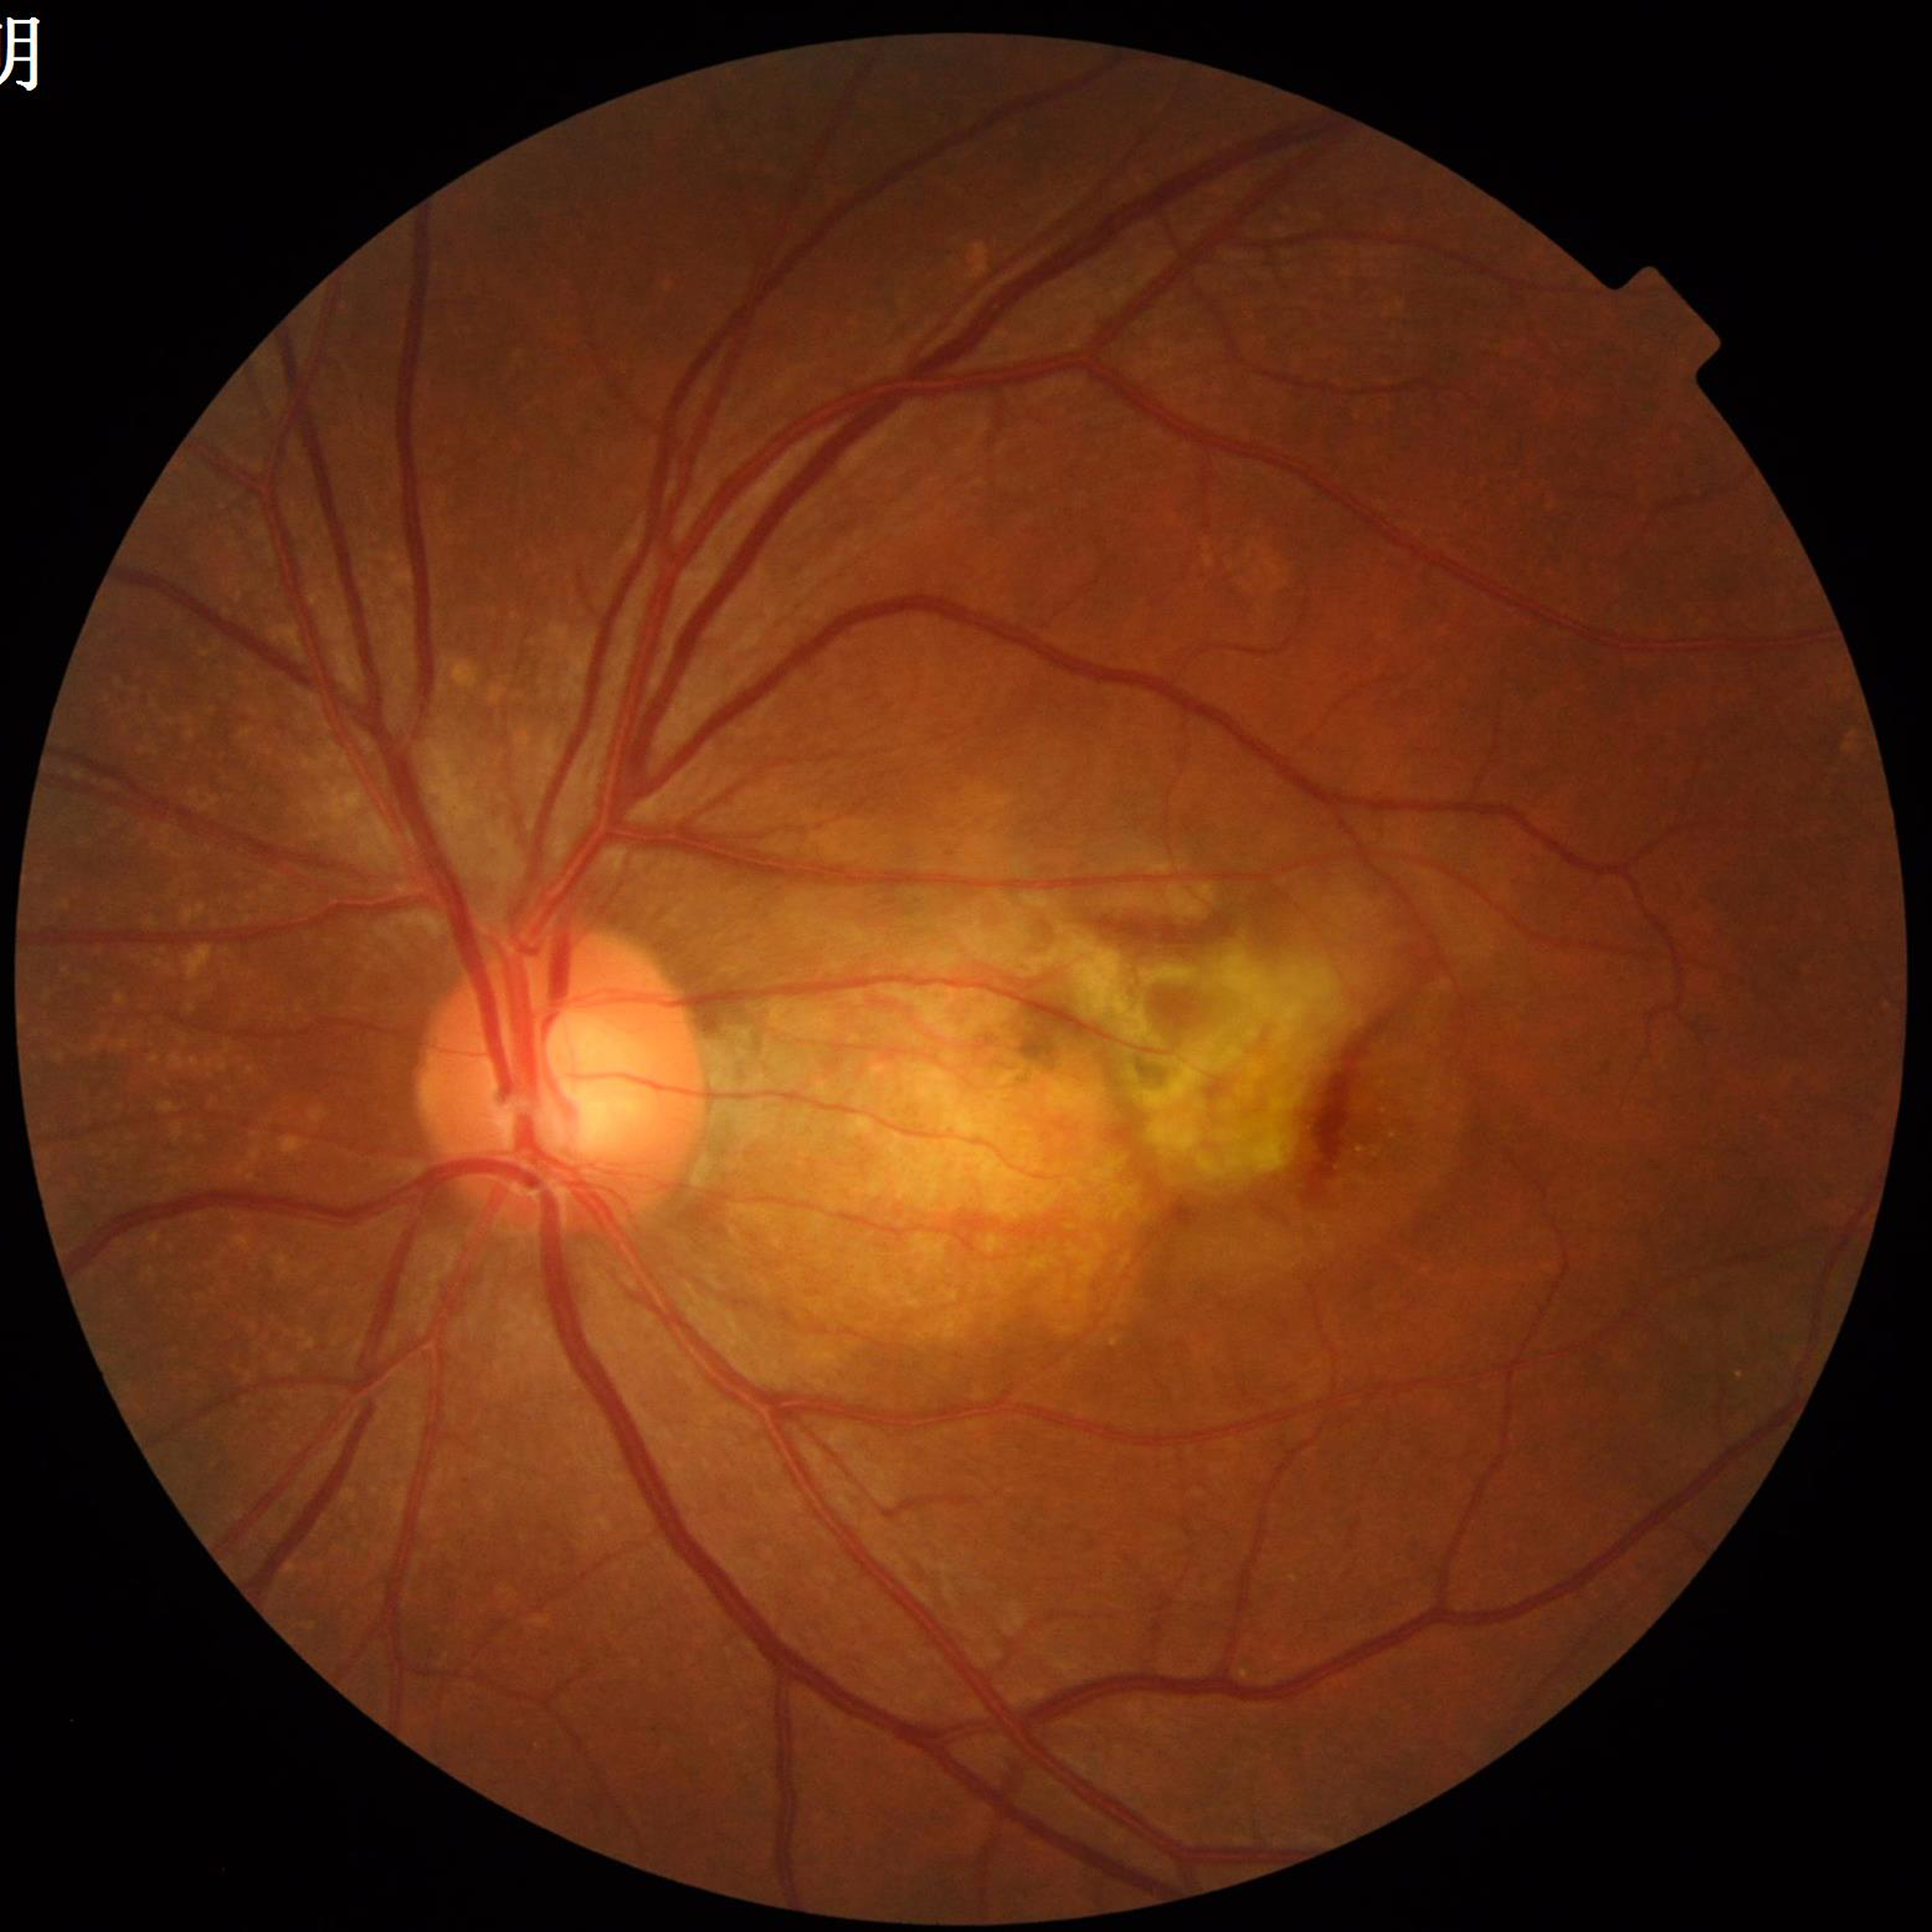 Diagnosed with age-related macular degeneration (AMD).